2228 by 1652 pixels; fundus photo:
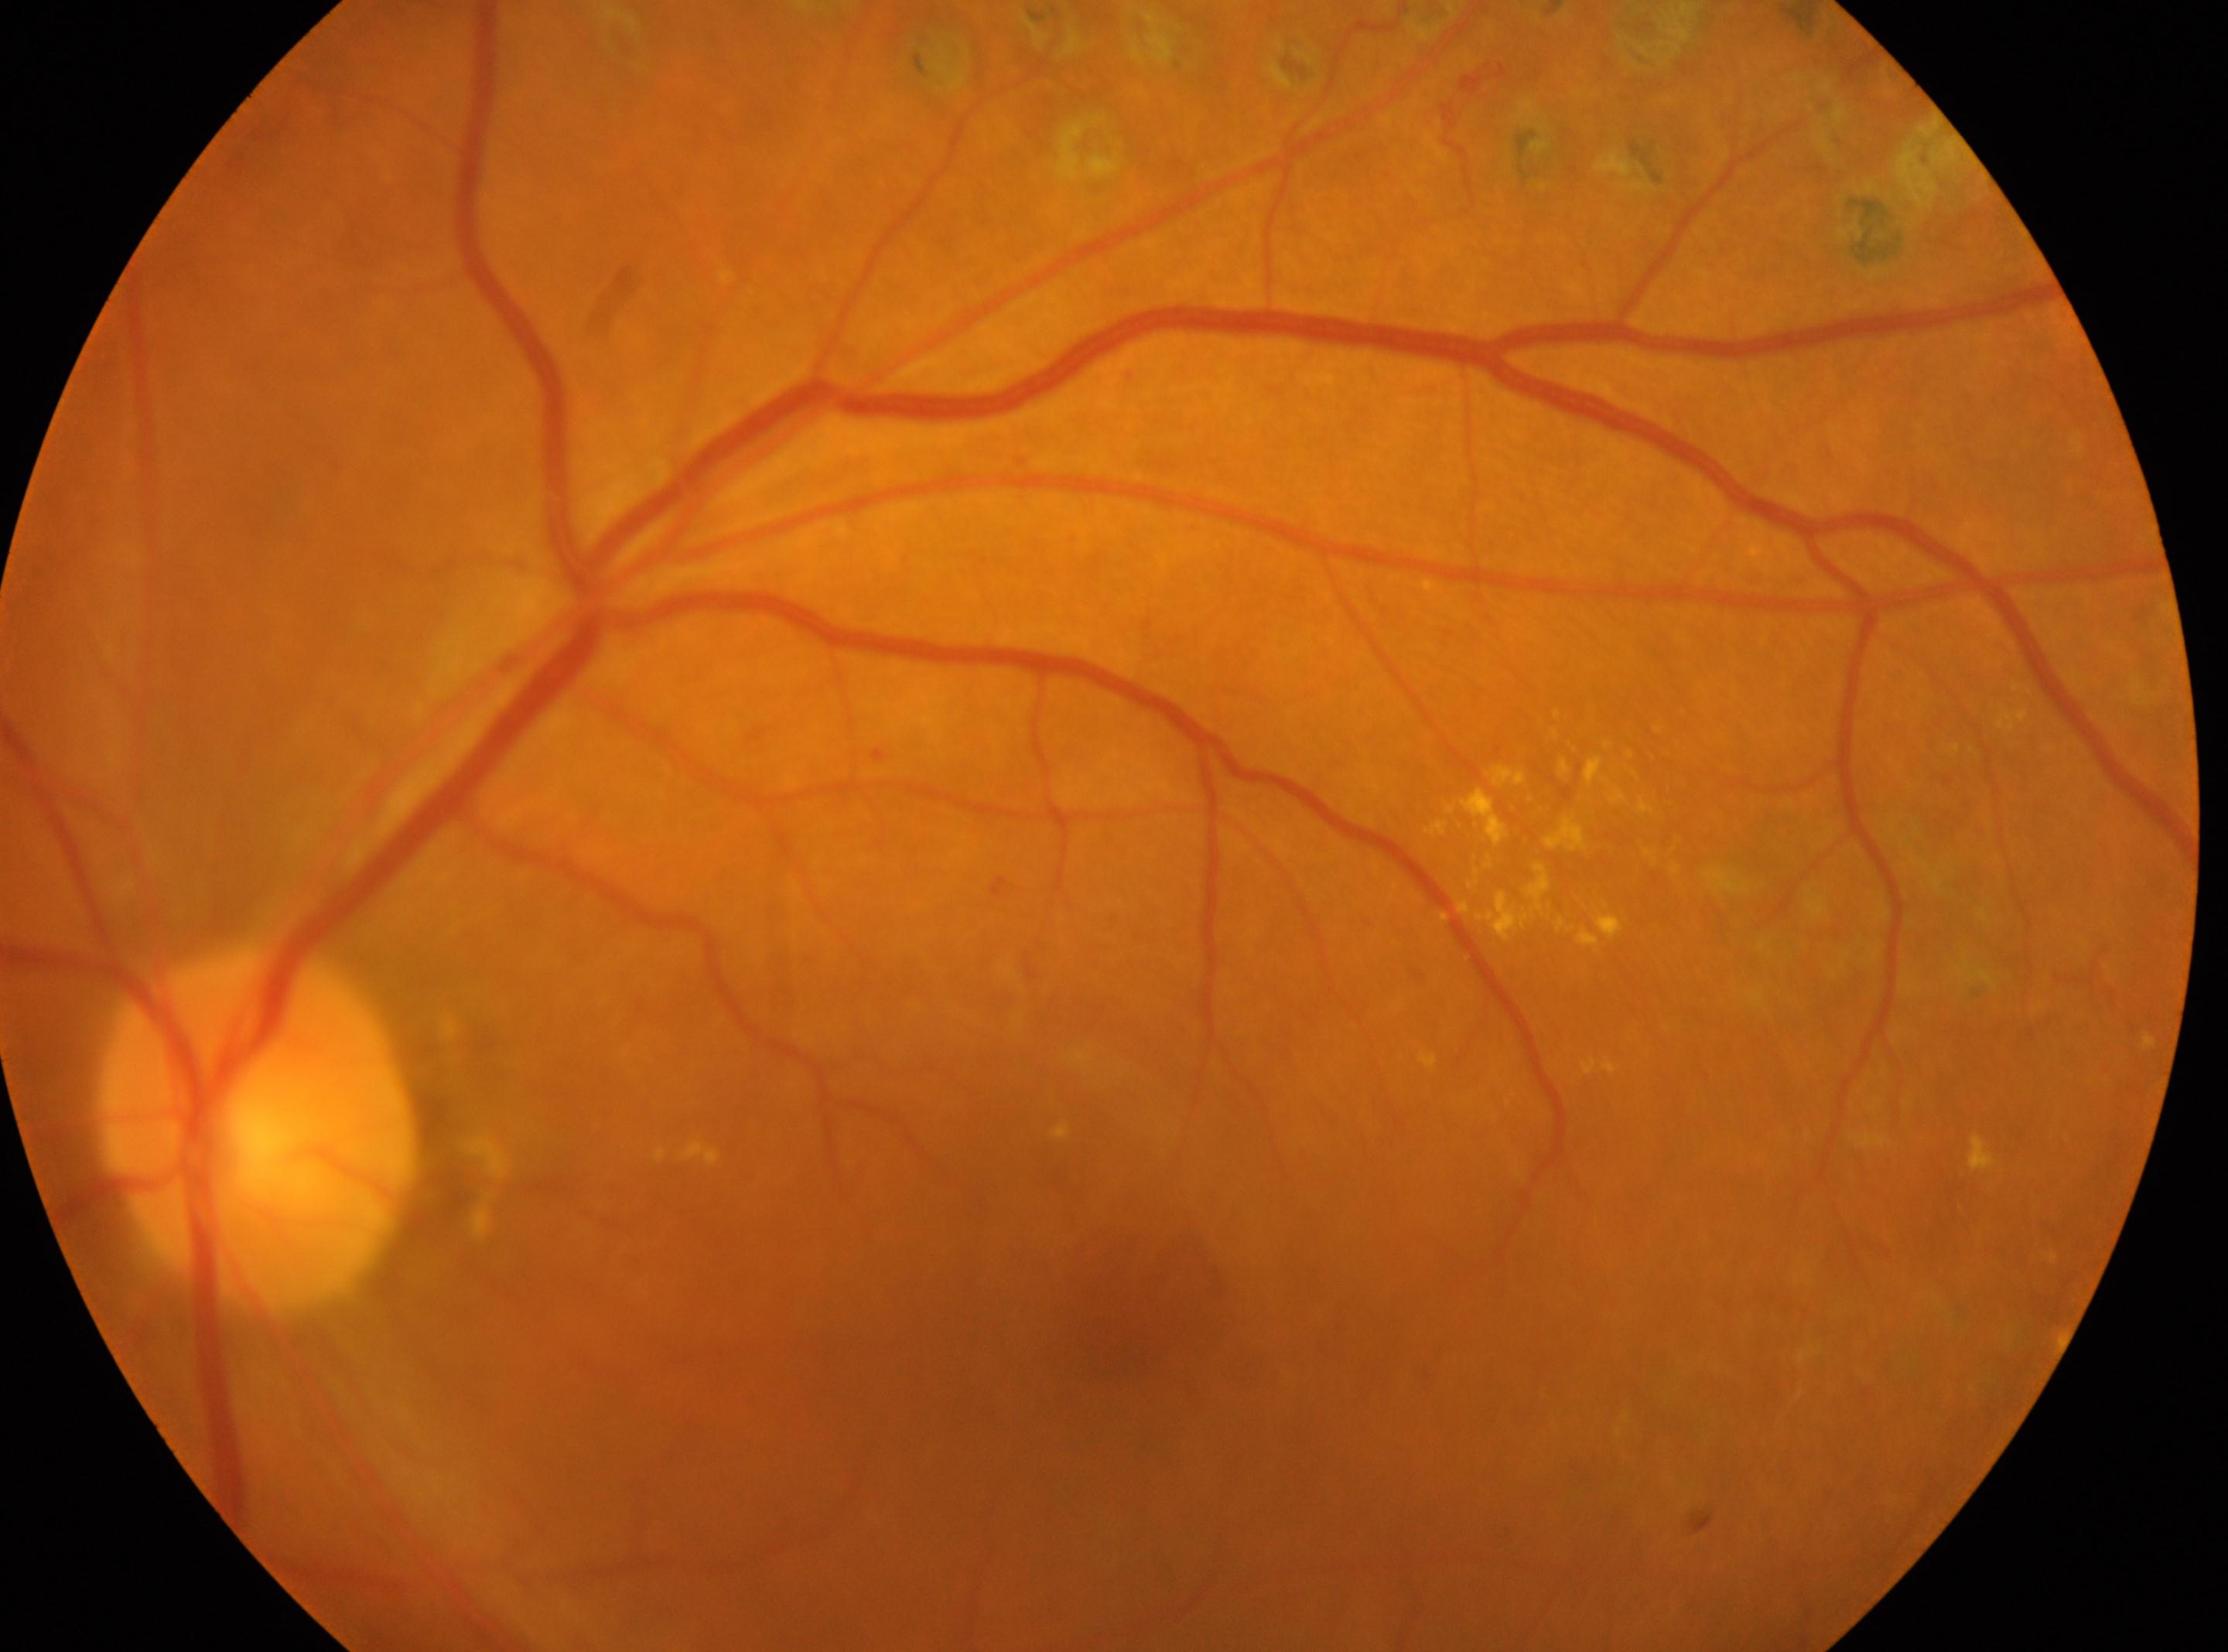
optic disk = 257px, 1129px | foveal center = 1109px, 1323px | laterality = oculus sinister | DR stage = post-photocoagulation DR — evidence of prior retinal laser photocoagulation (laser spots or scars).